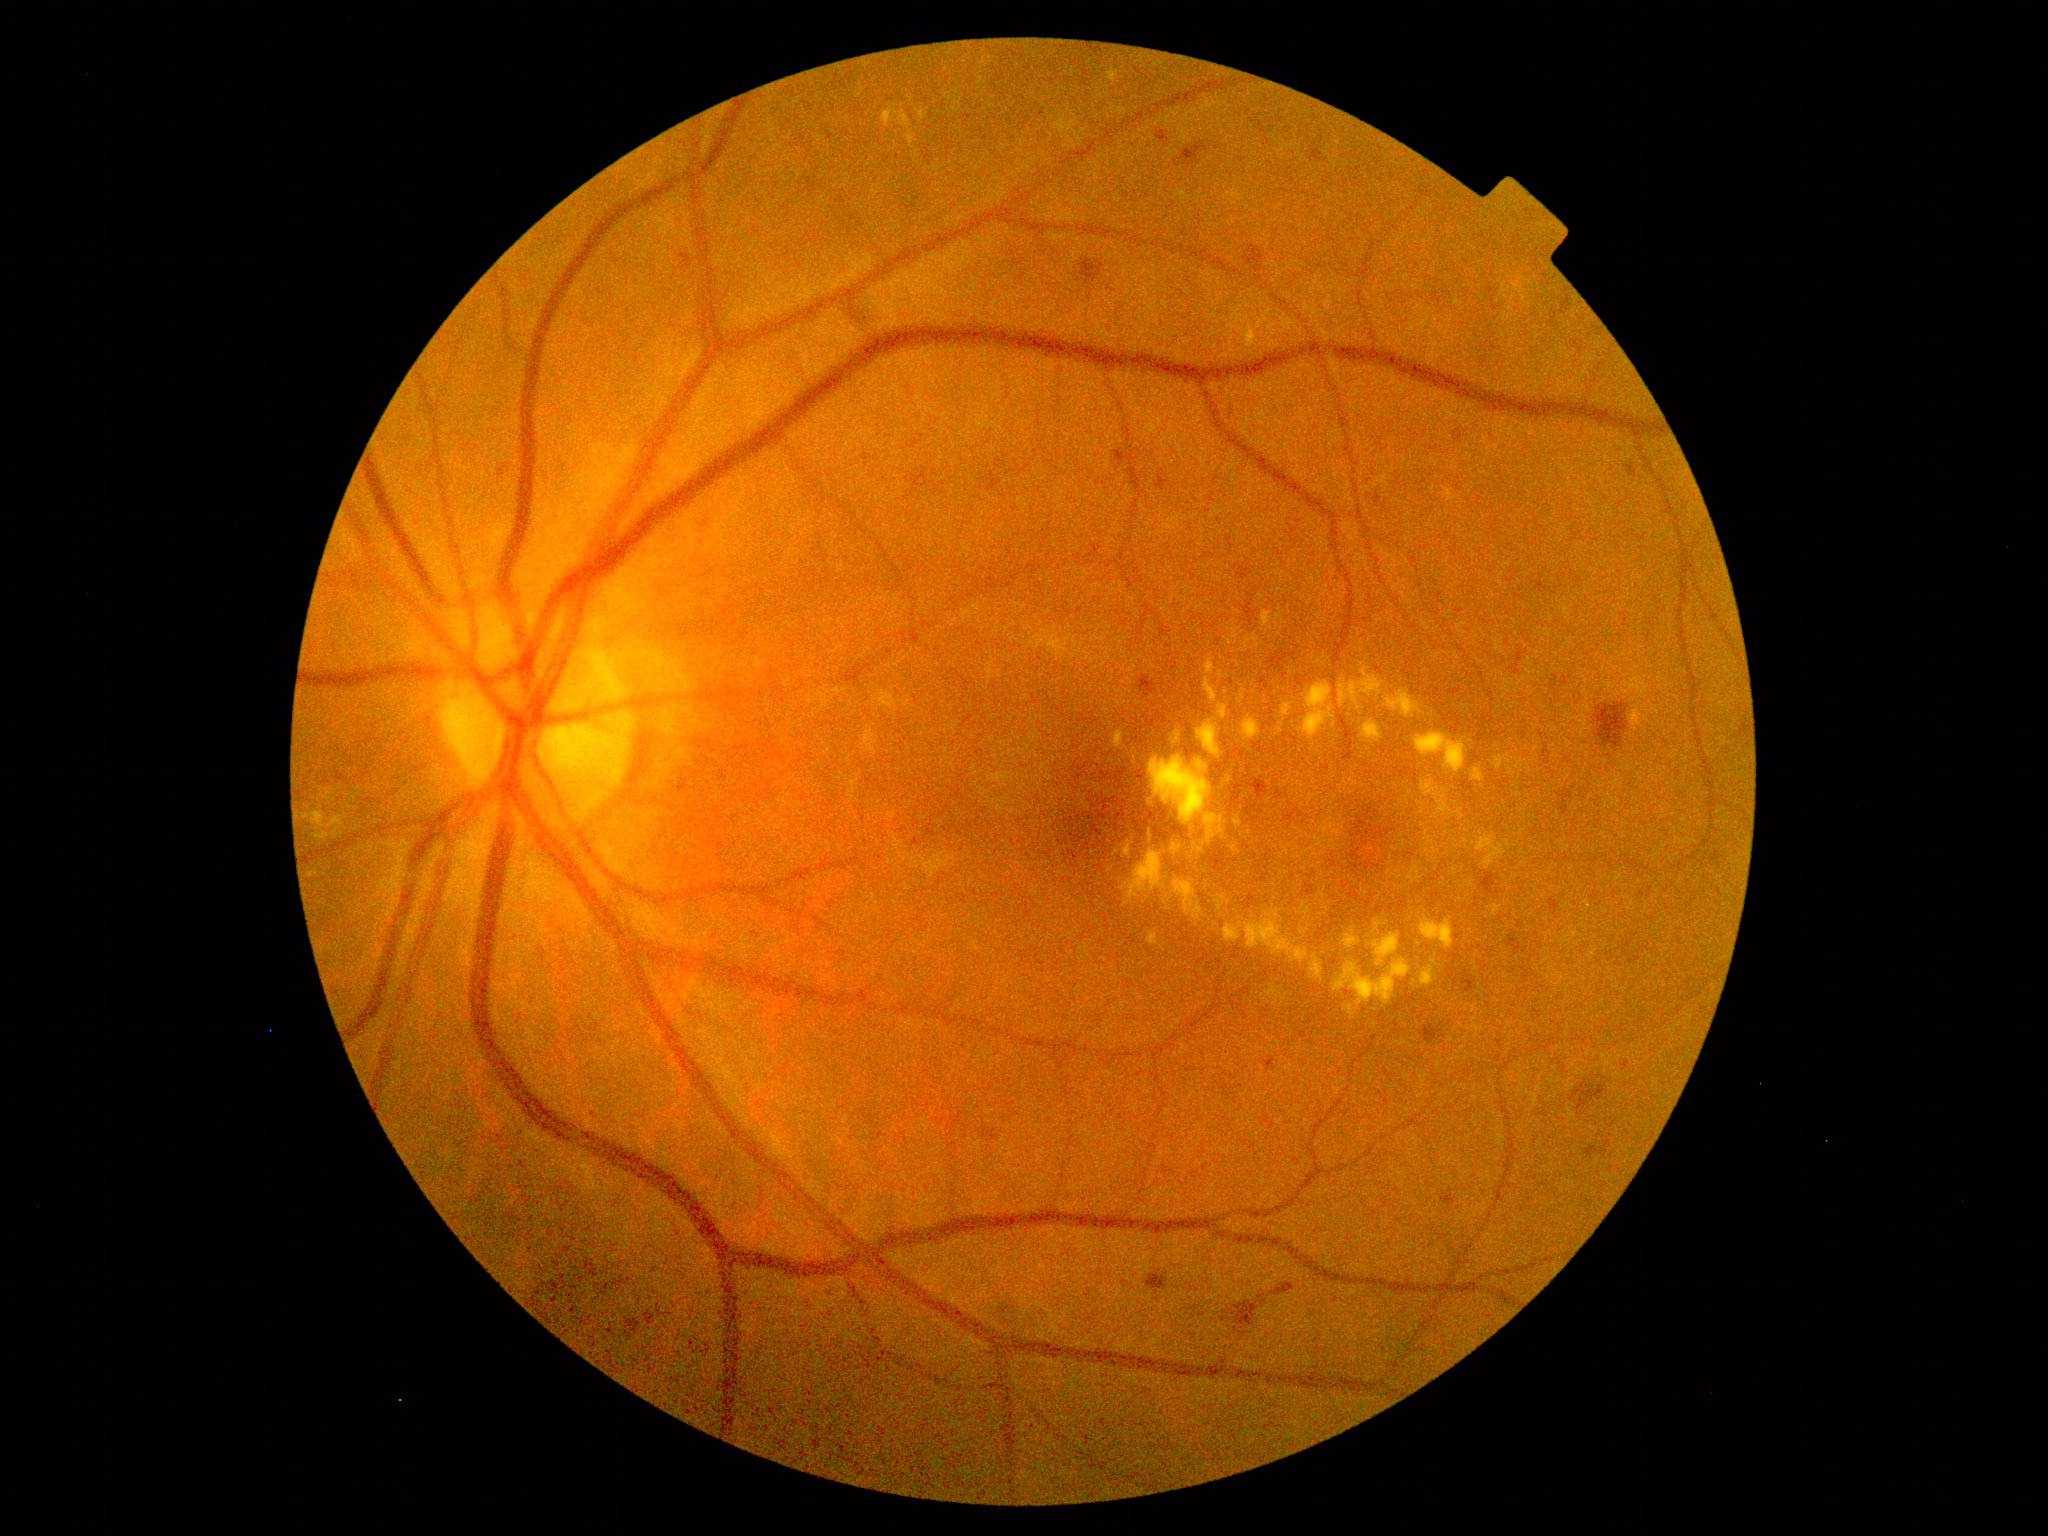

Diabetic retinopathy (DR): grade 2 (moderate NPDR); non-proliferative diabetic retinopathy
A subset of detected lesions:
- hard exudates (EXs) (subset): (1307, 793, 1322, 808), (1295, 783, 1305, 789), (1367, 934, 1401, 967), (1242, 716, 1262, 742), (1310, 954, 1324, 981), (1394, 874, 1403, 879), (1345, 1005, 1355, 1014), (1334, 958, 1413, 1007), (1172, 732, 1182, 745)
- Smaller EXs around (1143; 966), (1520; 684), (1130; 681), (1315; 823), (1129; 692), (1282; 856), (1403; 803), (1471; 931), (1448; 853), (1474; 844)
- hemorrhages (HEs) (subset): (1166, 820, 1189, 838), (1079, 763, 1089, 773), (645, 1313, 655, 1326), (1454, 432, 1463, 441), (1238, 565, 1252, 580), (1351, 849, 1365, 871), (1211, 848, 1226, 872), (1480, 872, 1500, 896), (1570, 1081, 1608, 1111), (497, 465, 500, 475), (1549, 899, 1562, 912), (532, 1299, 539, 1307), (999, 1307, 1017, 1325), (1441, 1193, 1456, 1209), (1244, 246, 1267, 273)
- Smaller HEs around (1080; 818), (1084; 816), (1101; 844)